45° FOV · fundus photo — 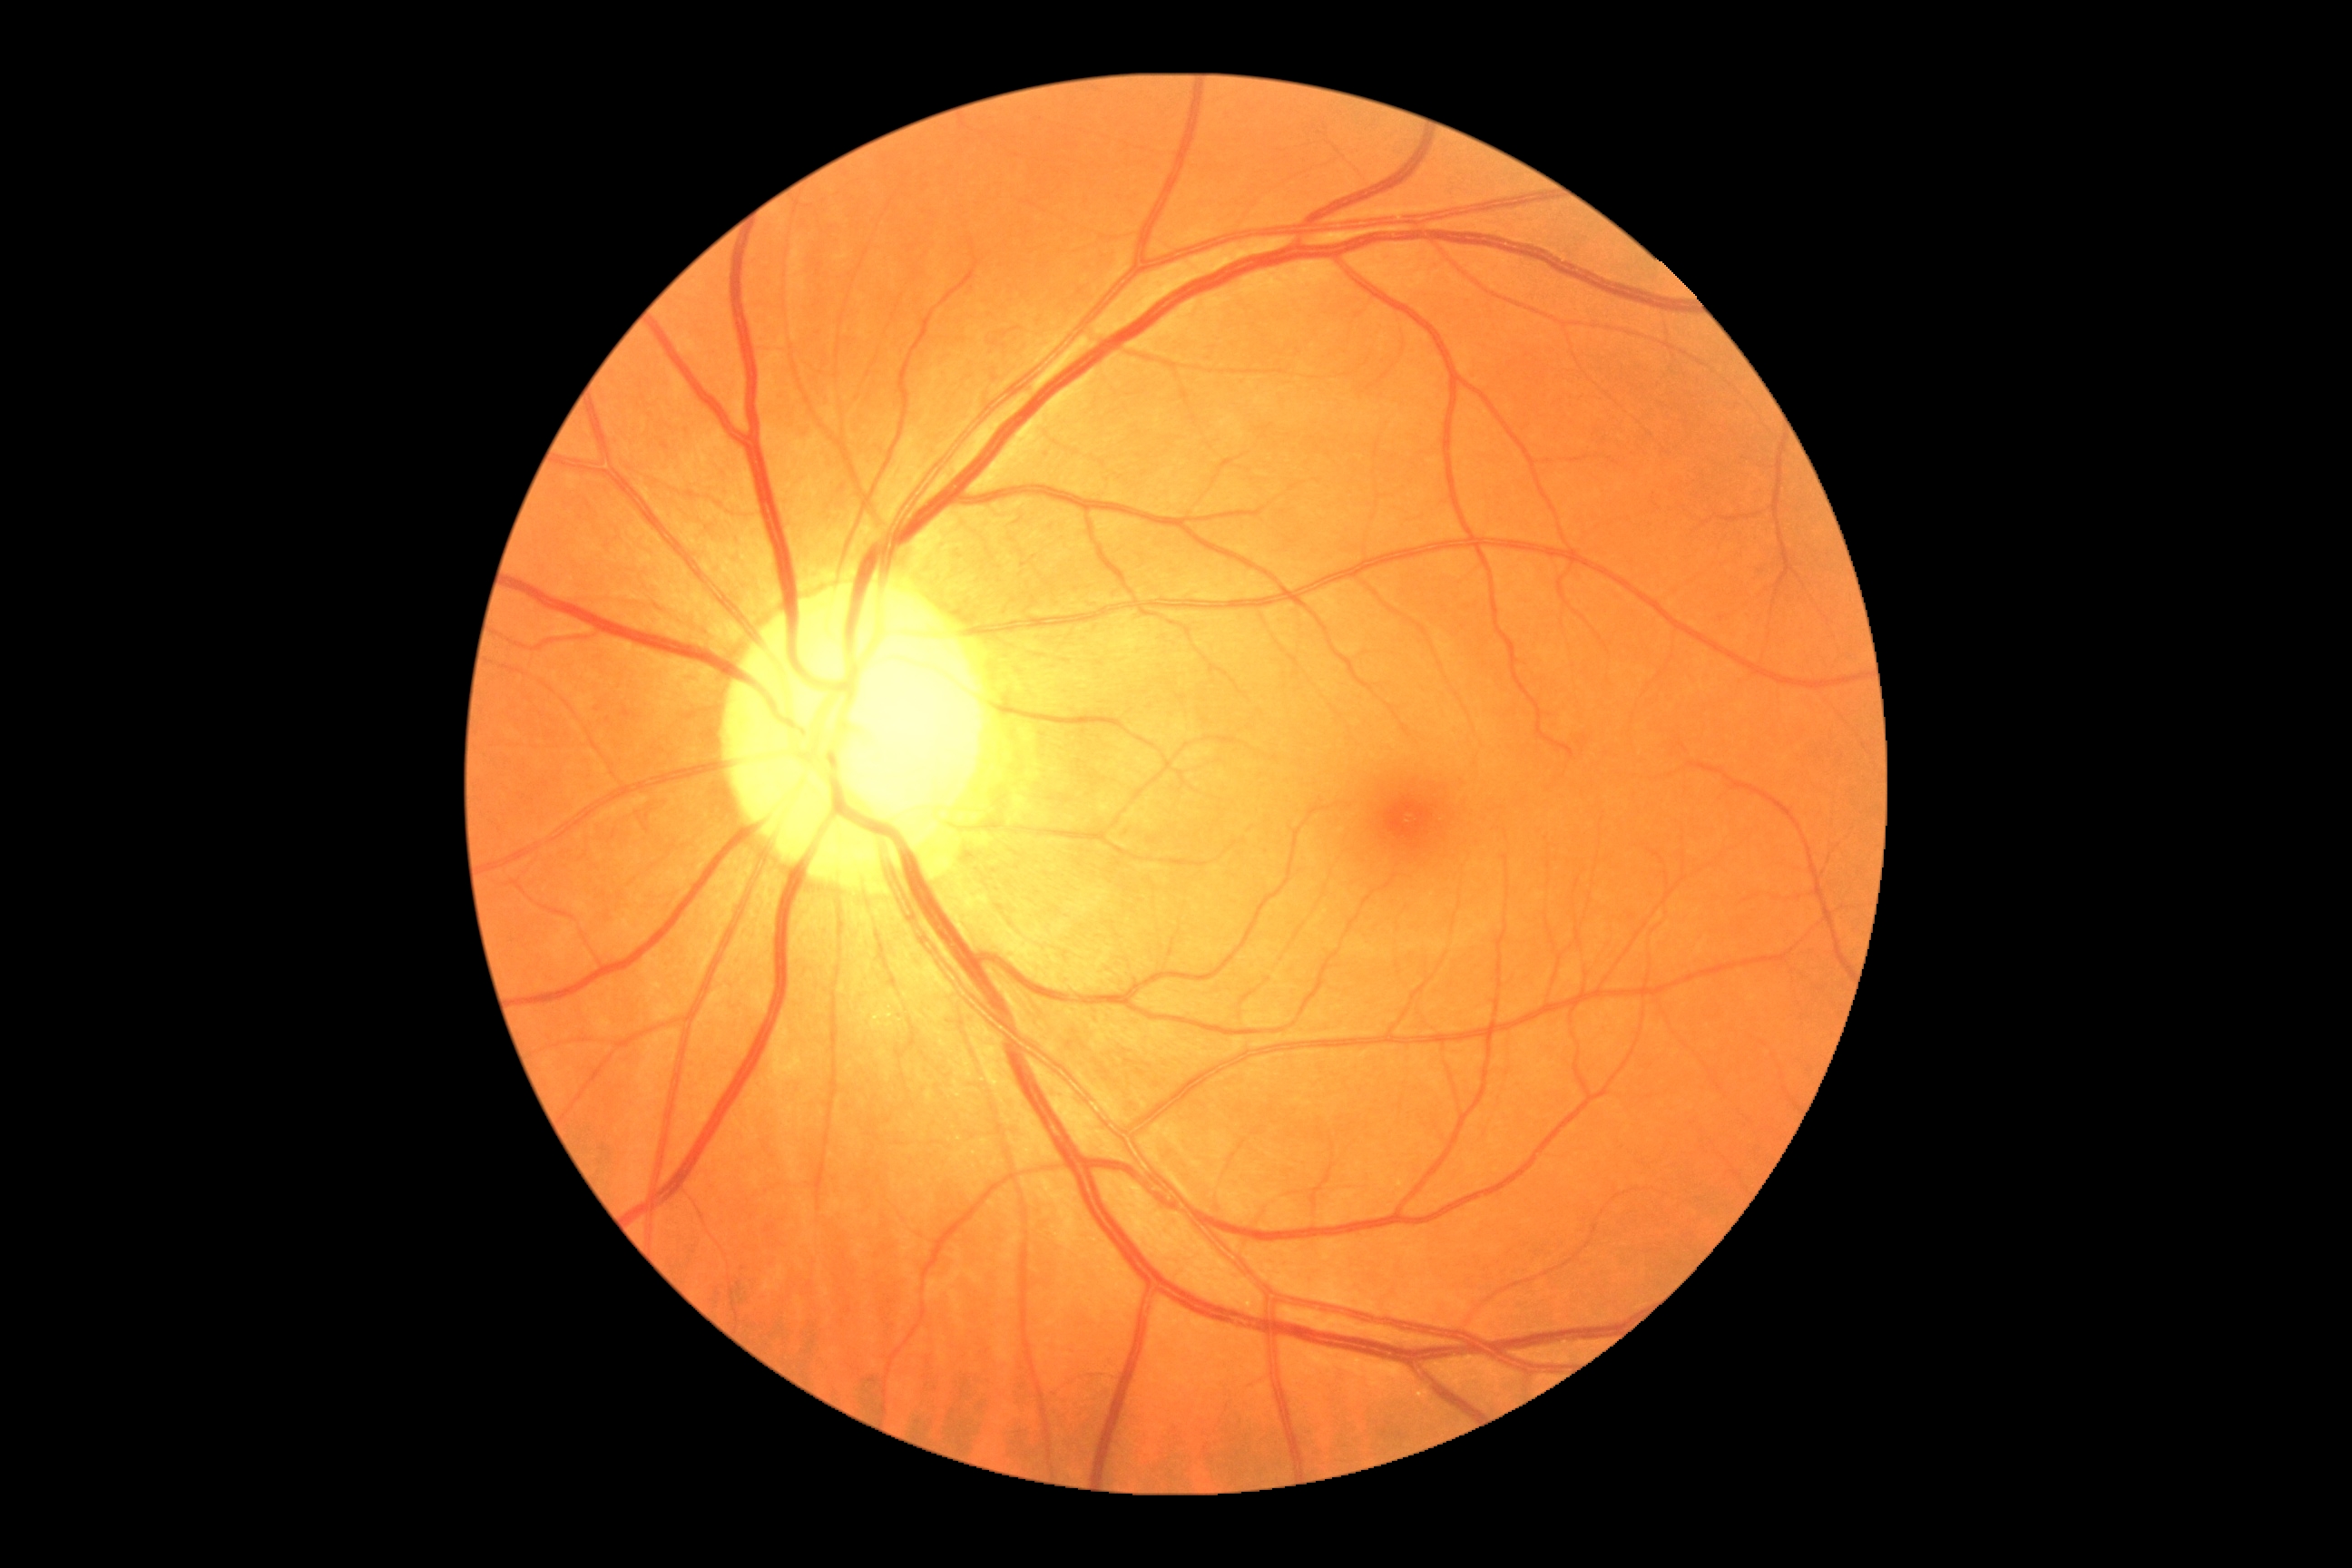 Retinopathy grade is 0/4.